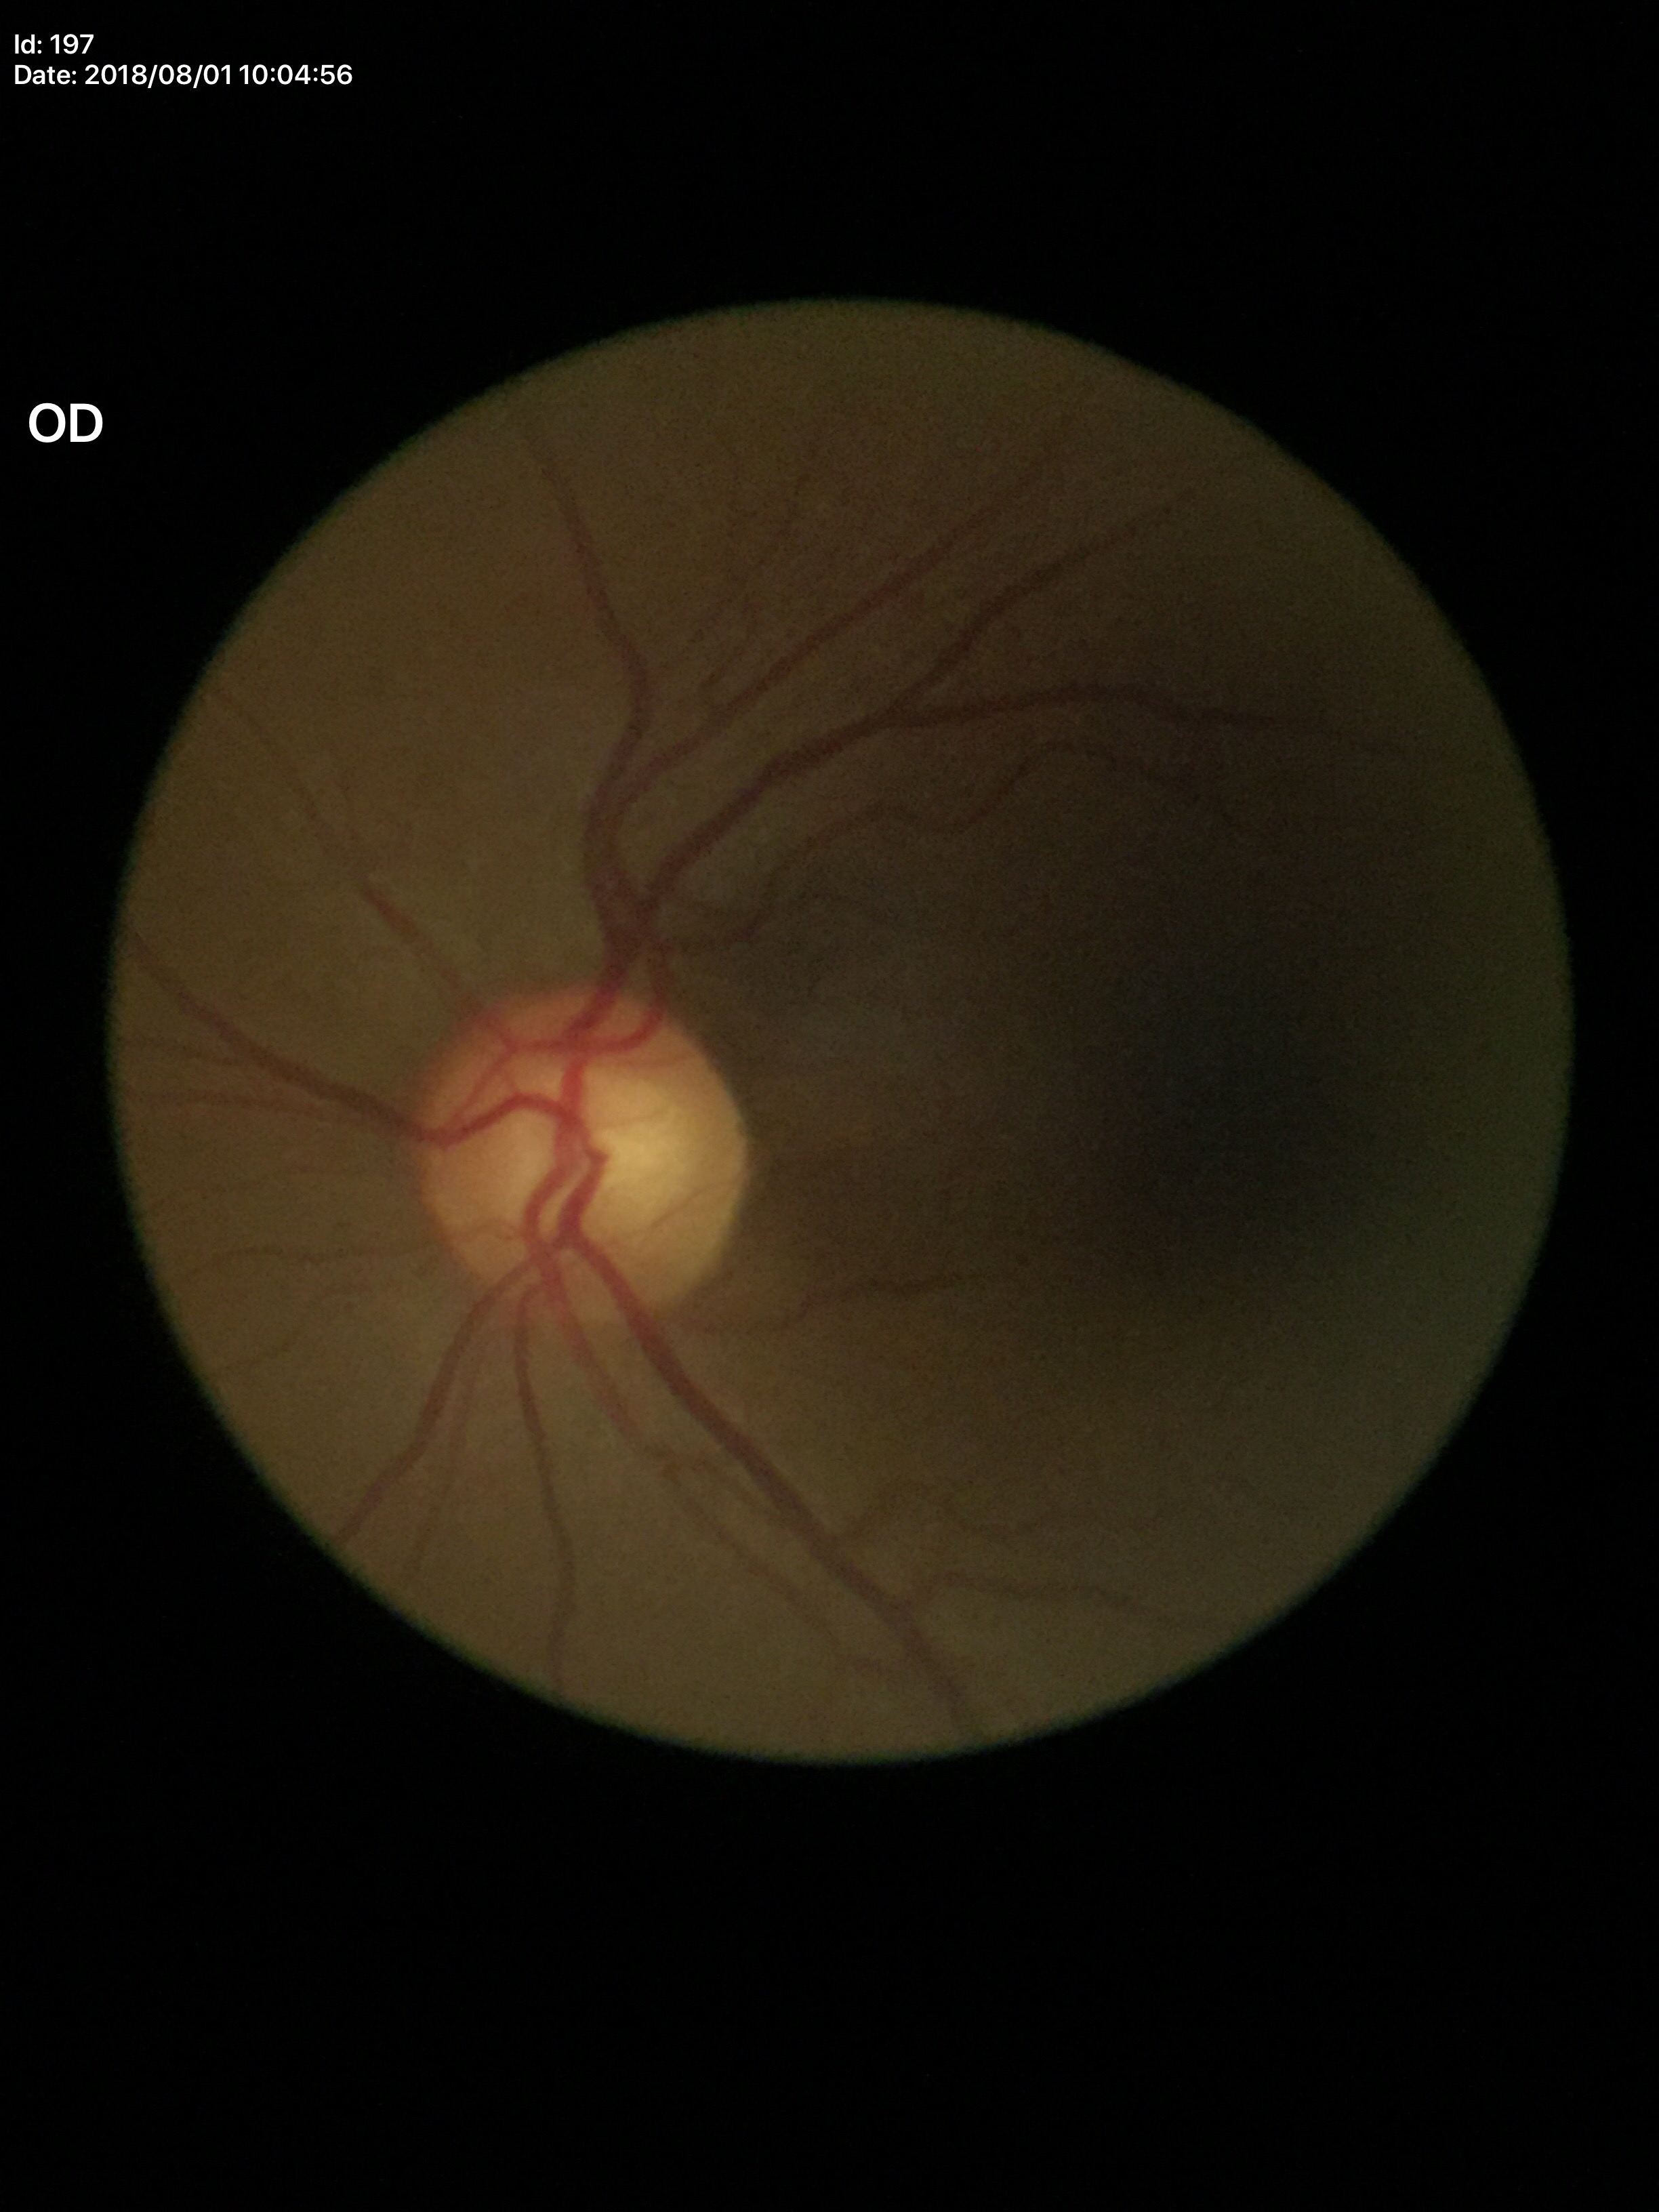

No signs of glaucoma. Vertical cup-disc ratio: 0.58. Horizontal cup-to-disc ratio is 0.62.